Clarity RetCam 3, 130° FOV · image size 640x480 · wide-field fundus photograph from neonatal ROP screening.
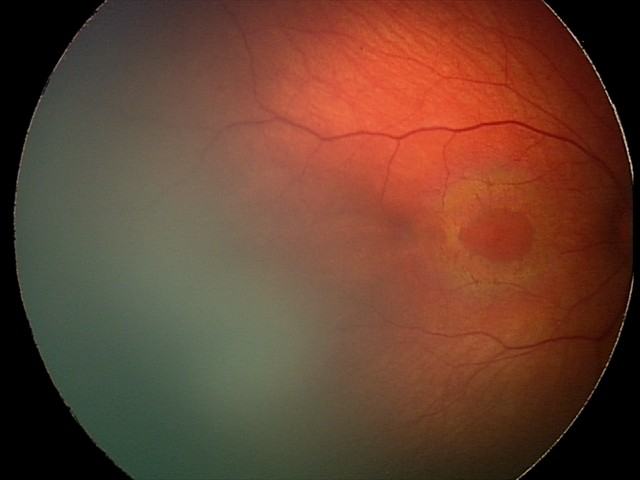 Series diagnosed as retinal hemorrhages.